RetCam wide-field infant fundus image; Clarity RetCam 3, 130° FOV; image size 640x480: 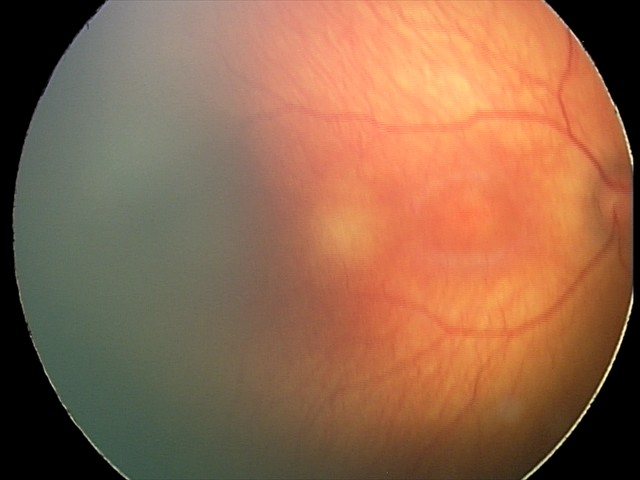

Normal screening examination.